Retinal fundus photograph:
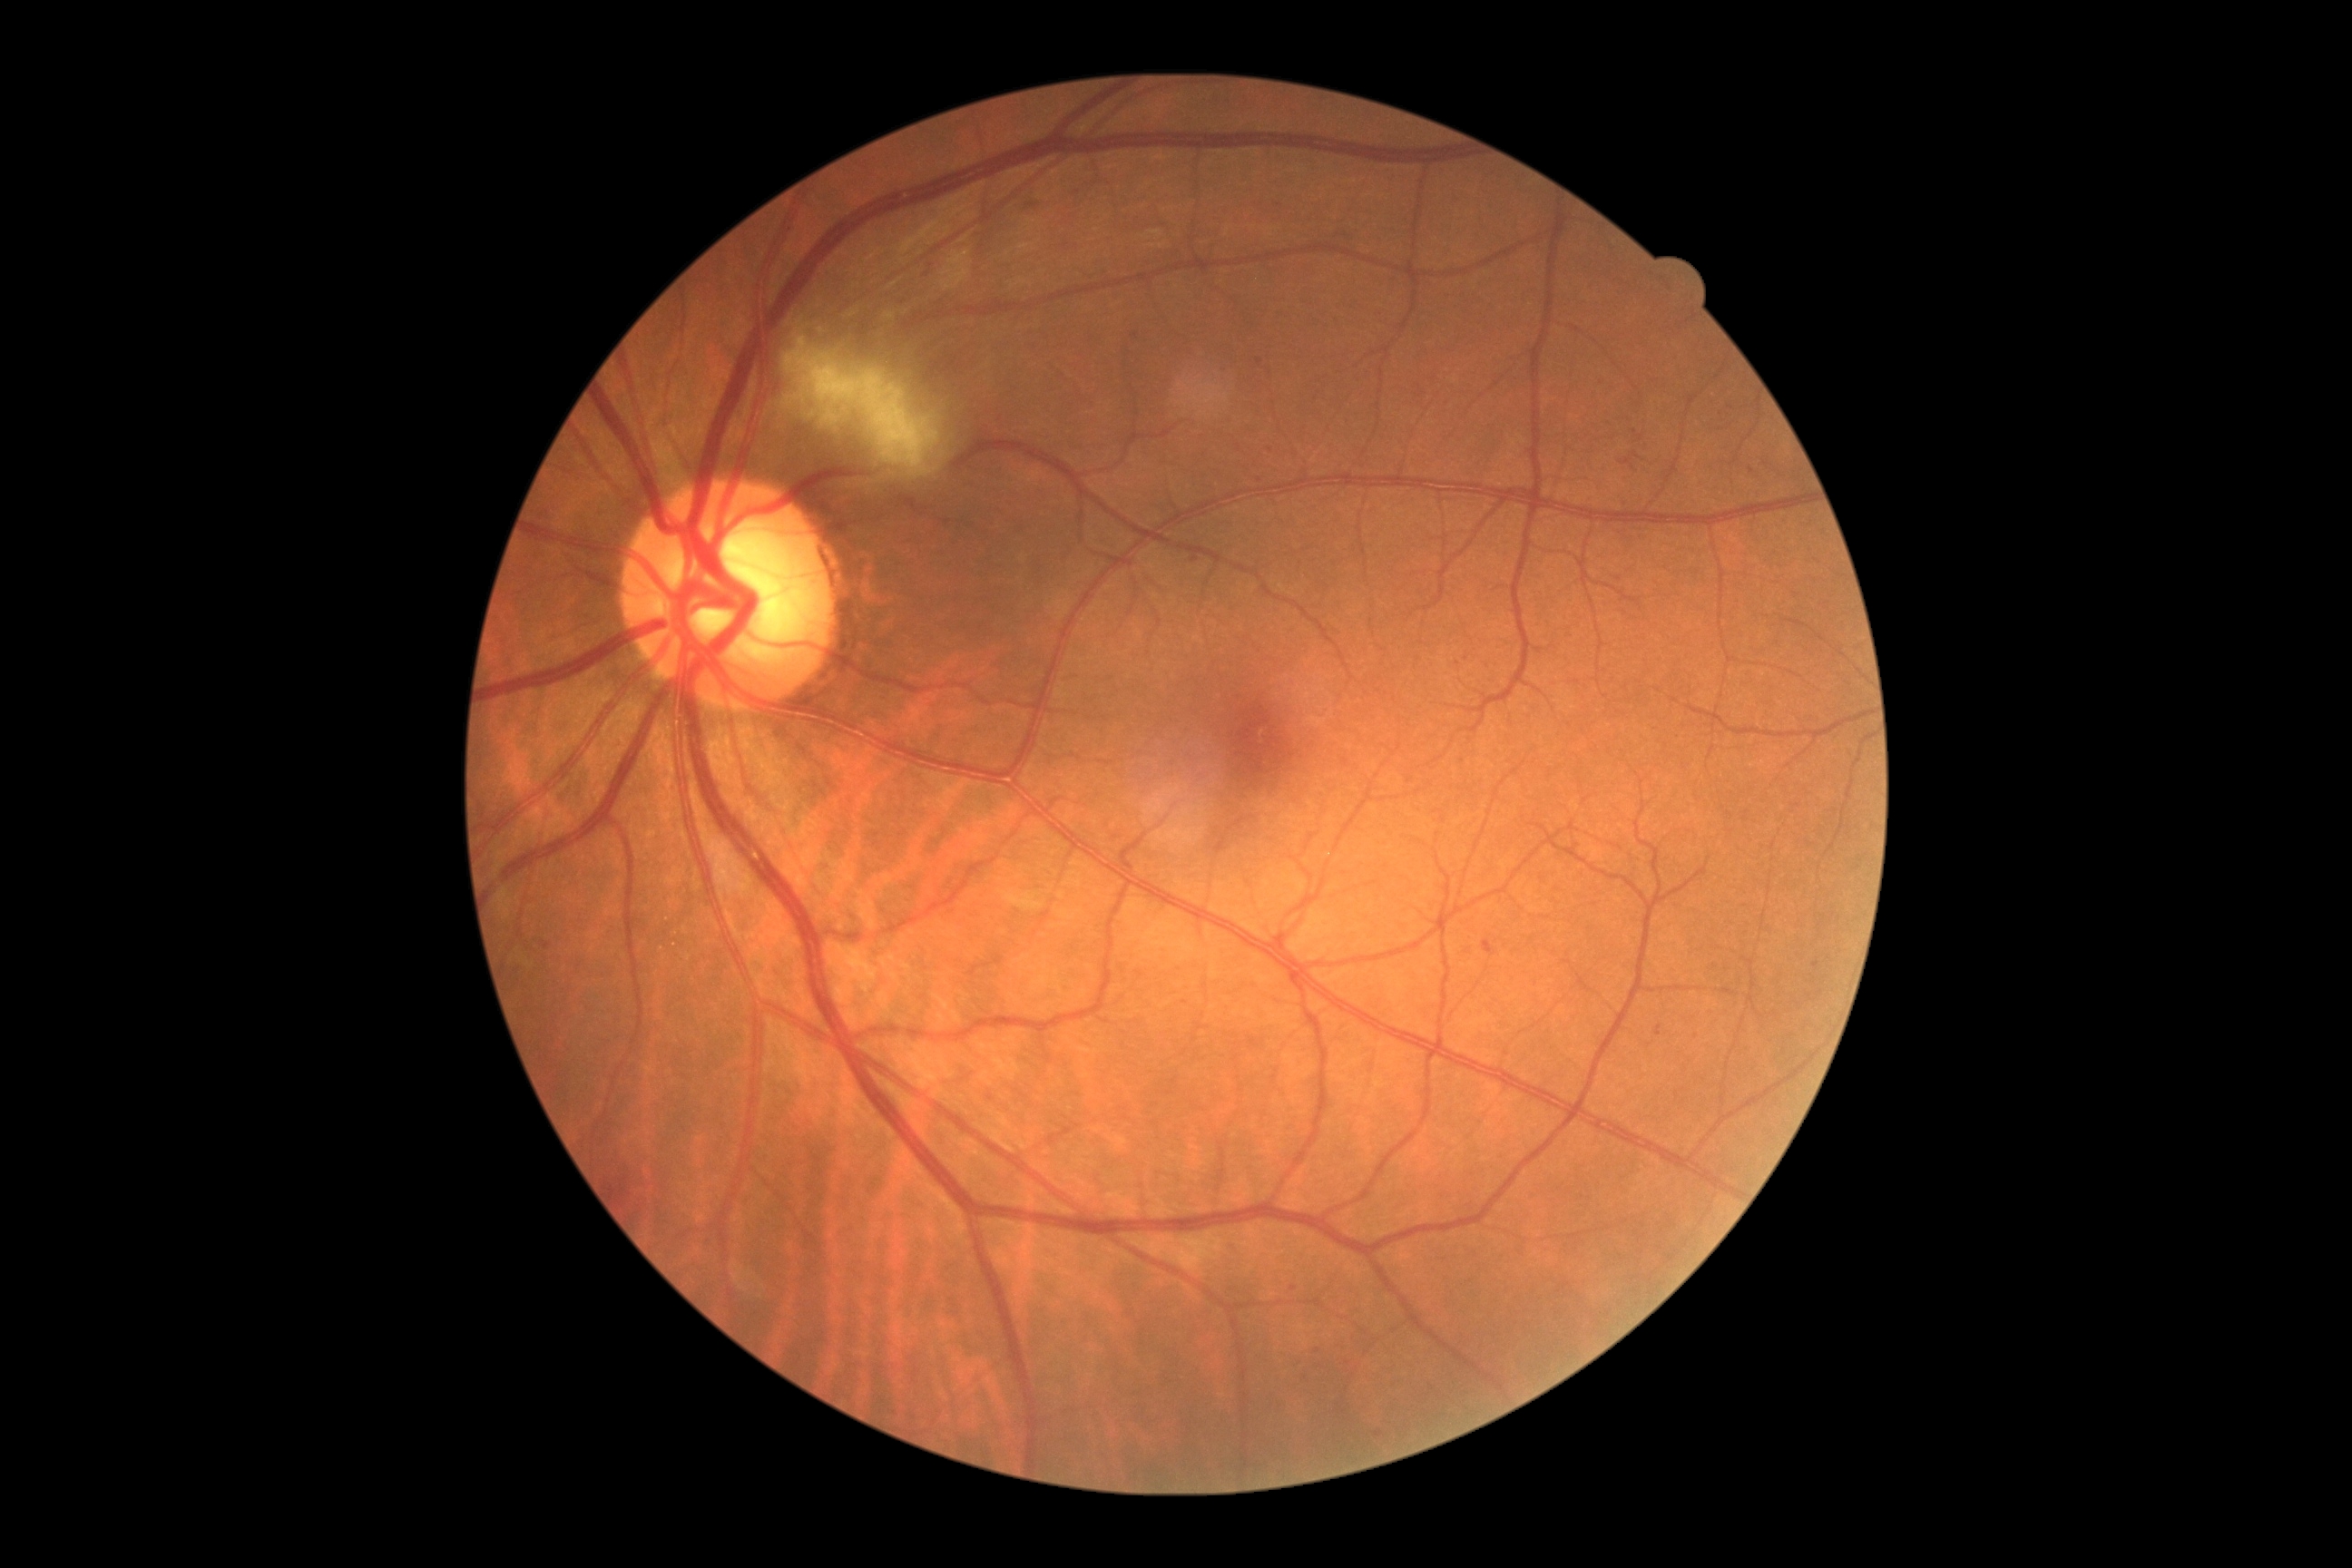 Disease class: non-proliferative diabetic retinopathy. DR is grade 2 — more than just microaneurysms but less than severe NPDR.